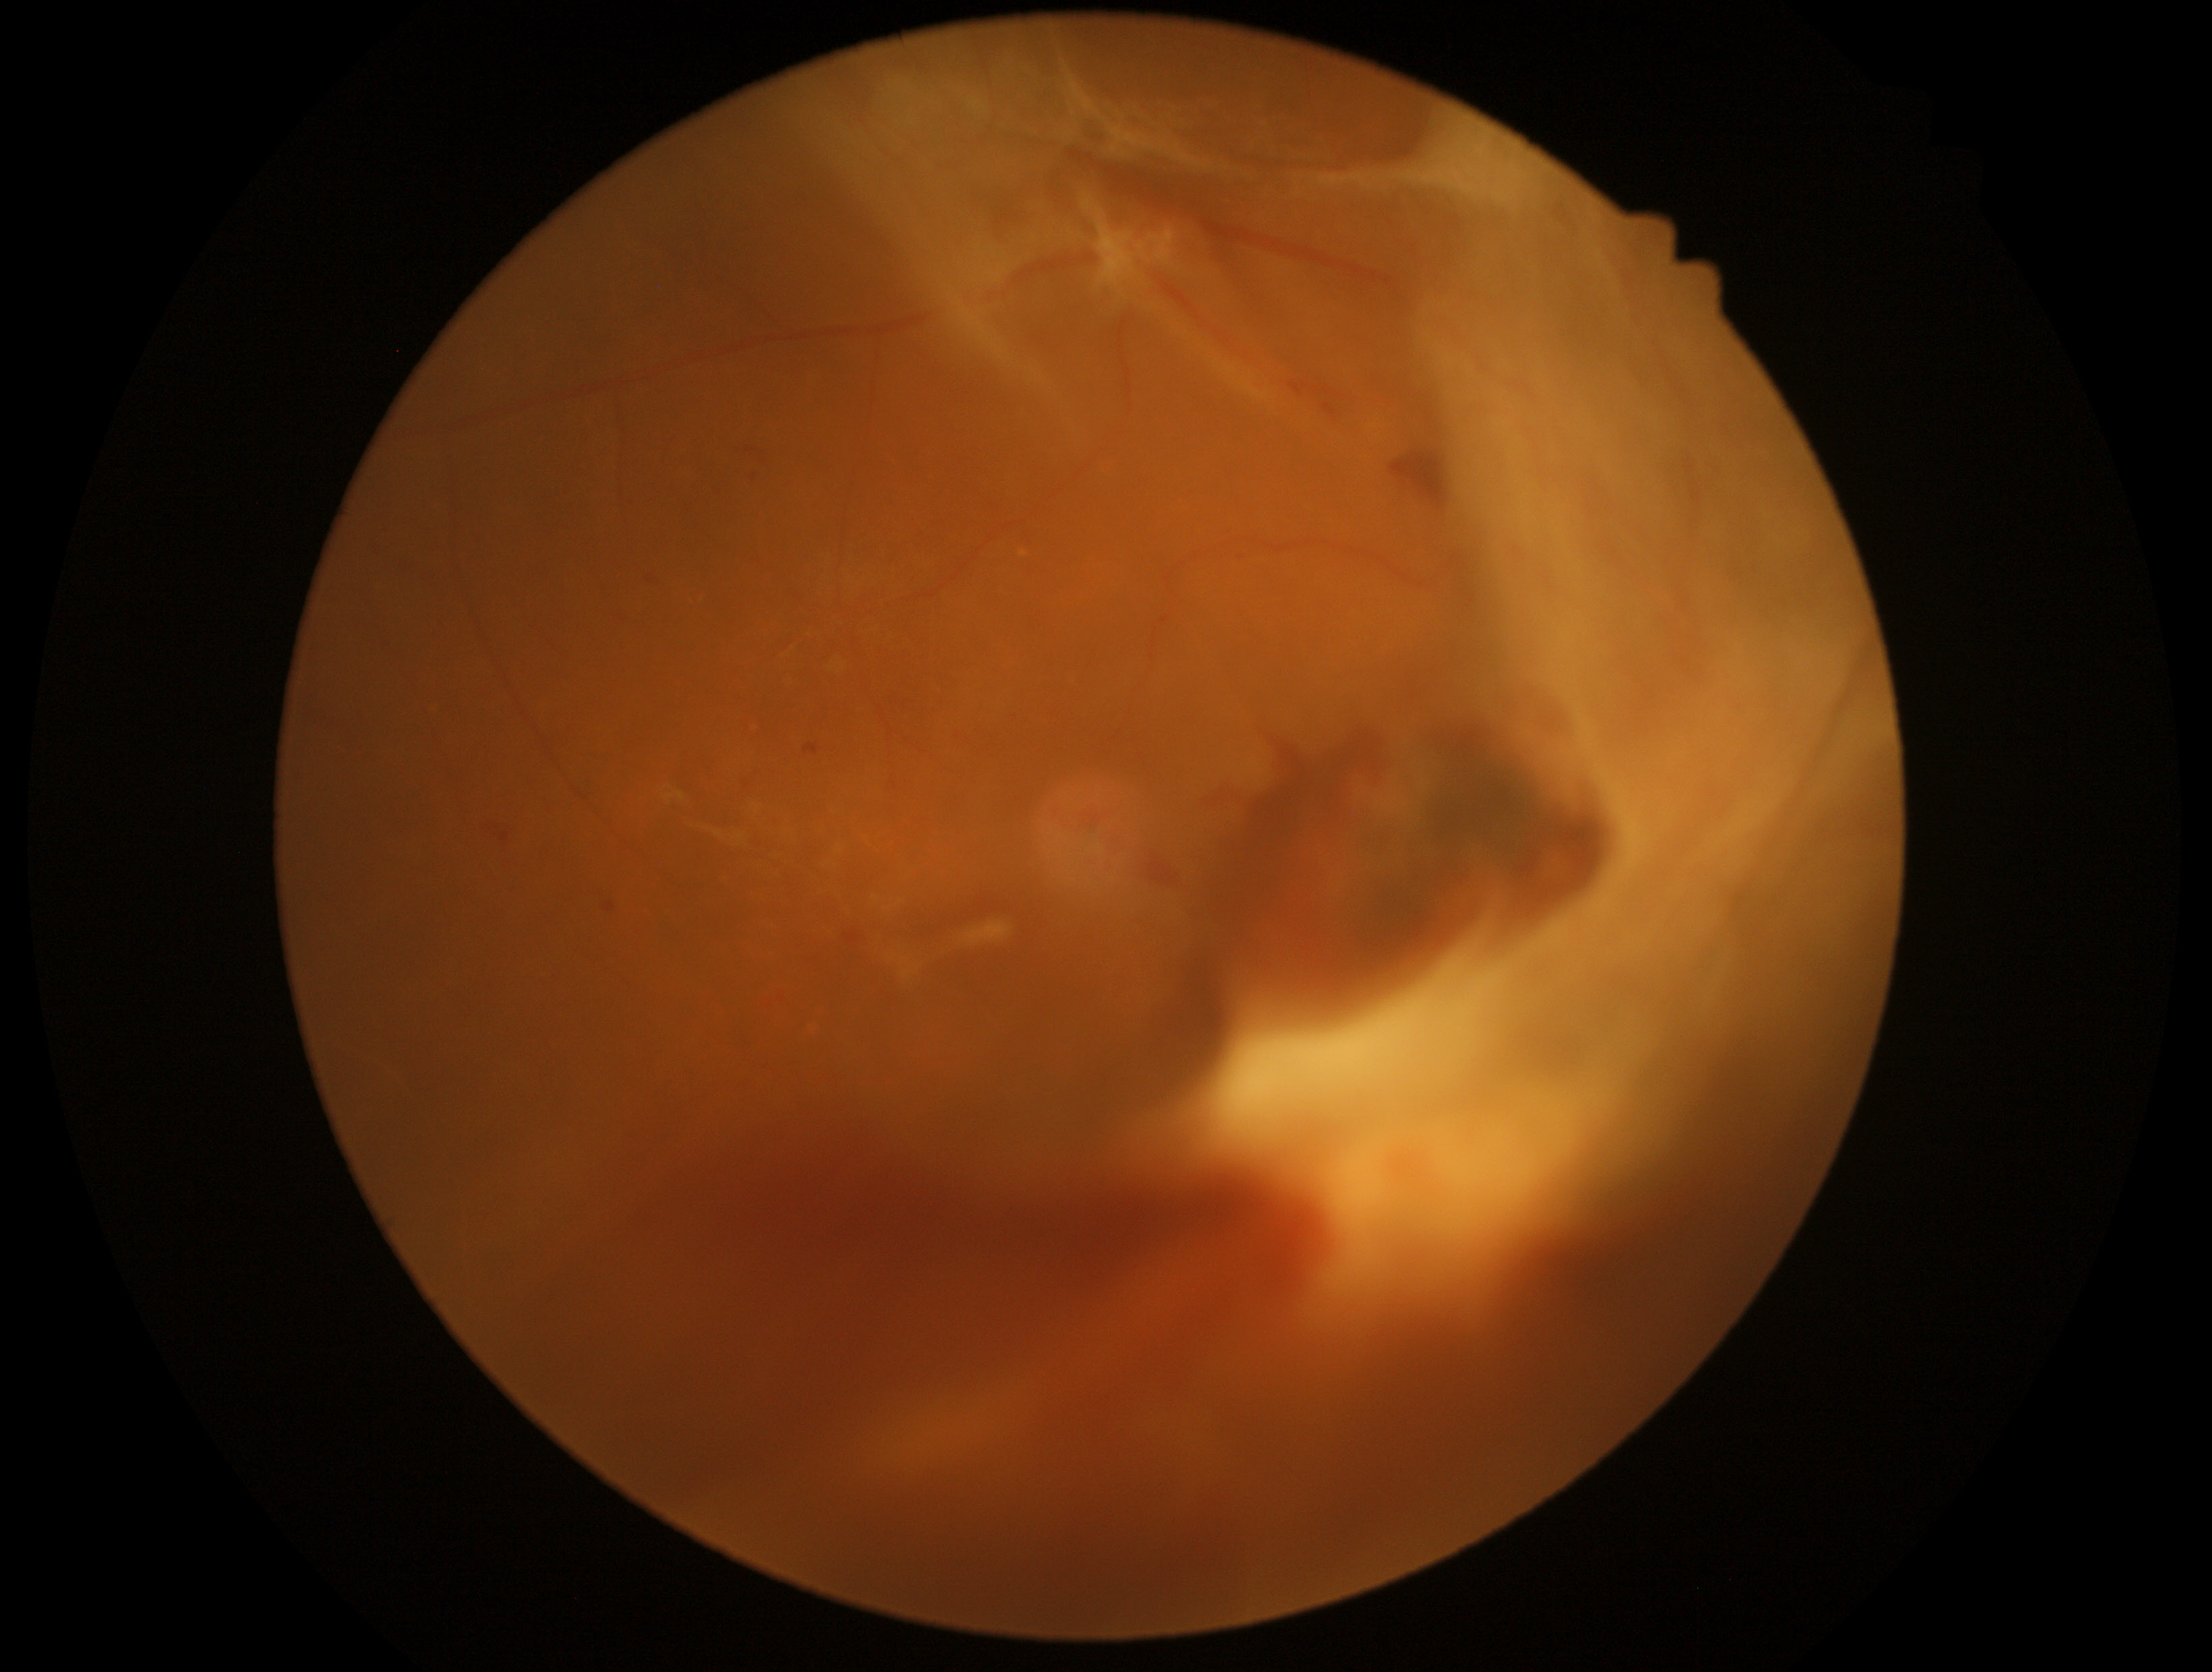 Diabetic retinopathy (DR) is grade 4 (PDR). The retinopathy is classified as proliferative diabetic retinopathy.